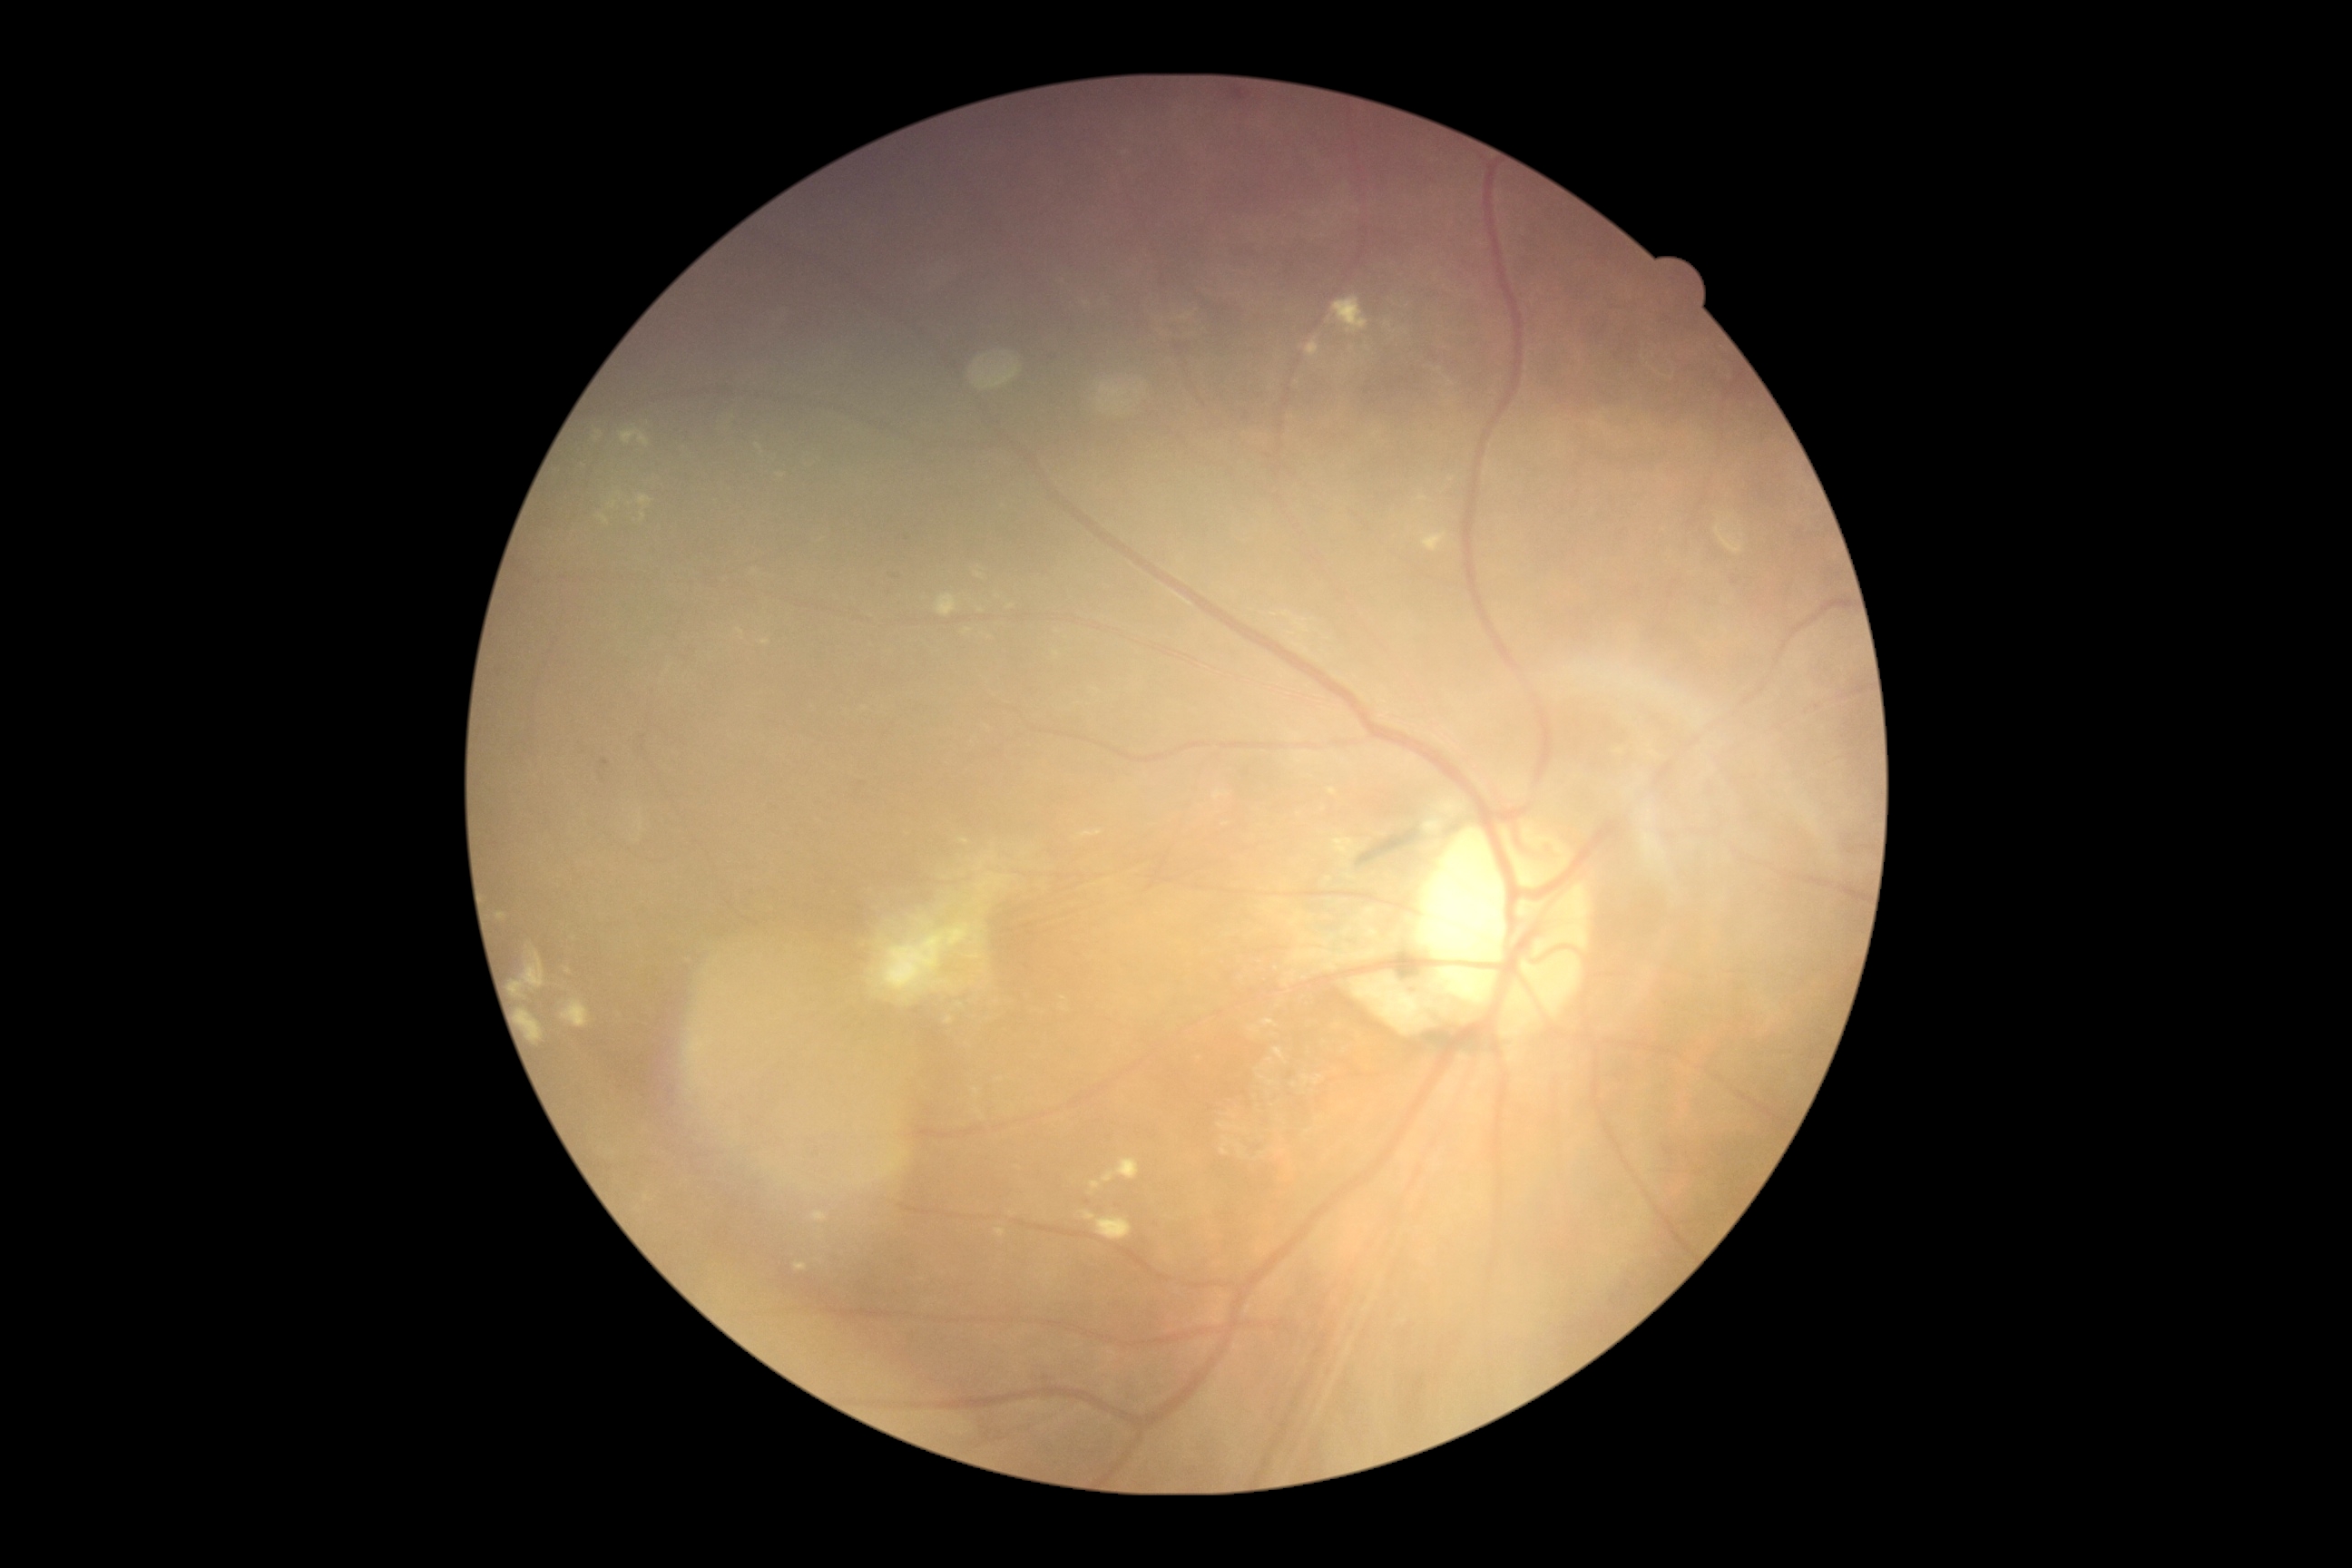

DR stage: grade 2 (moderate NPDR).